1659 x 2212 pixels: 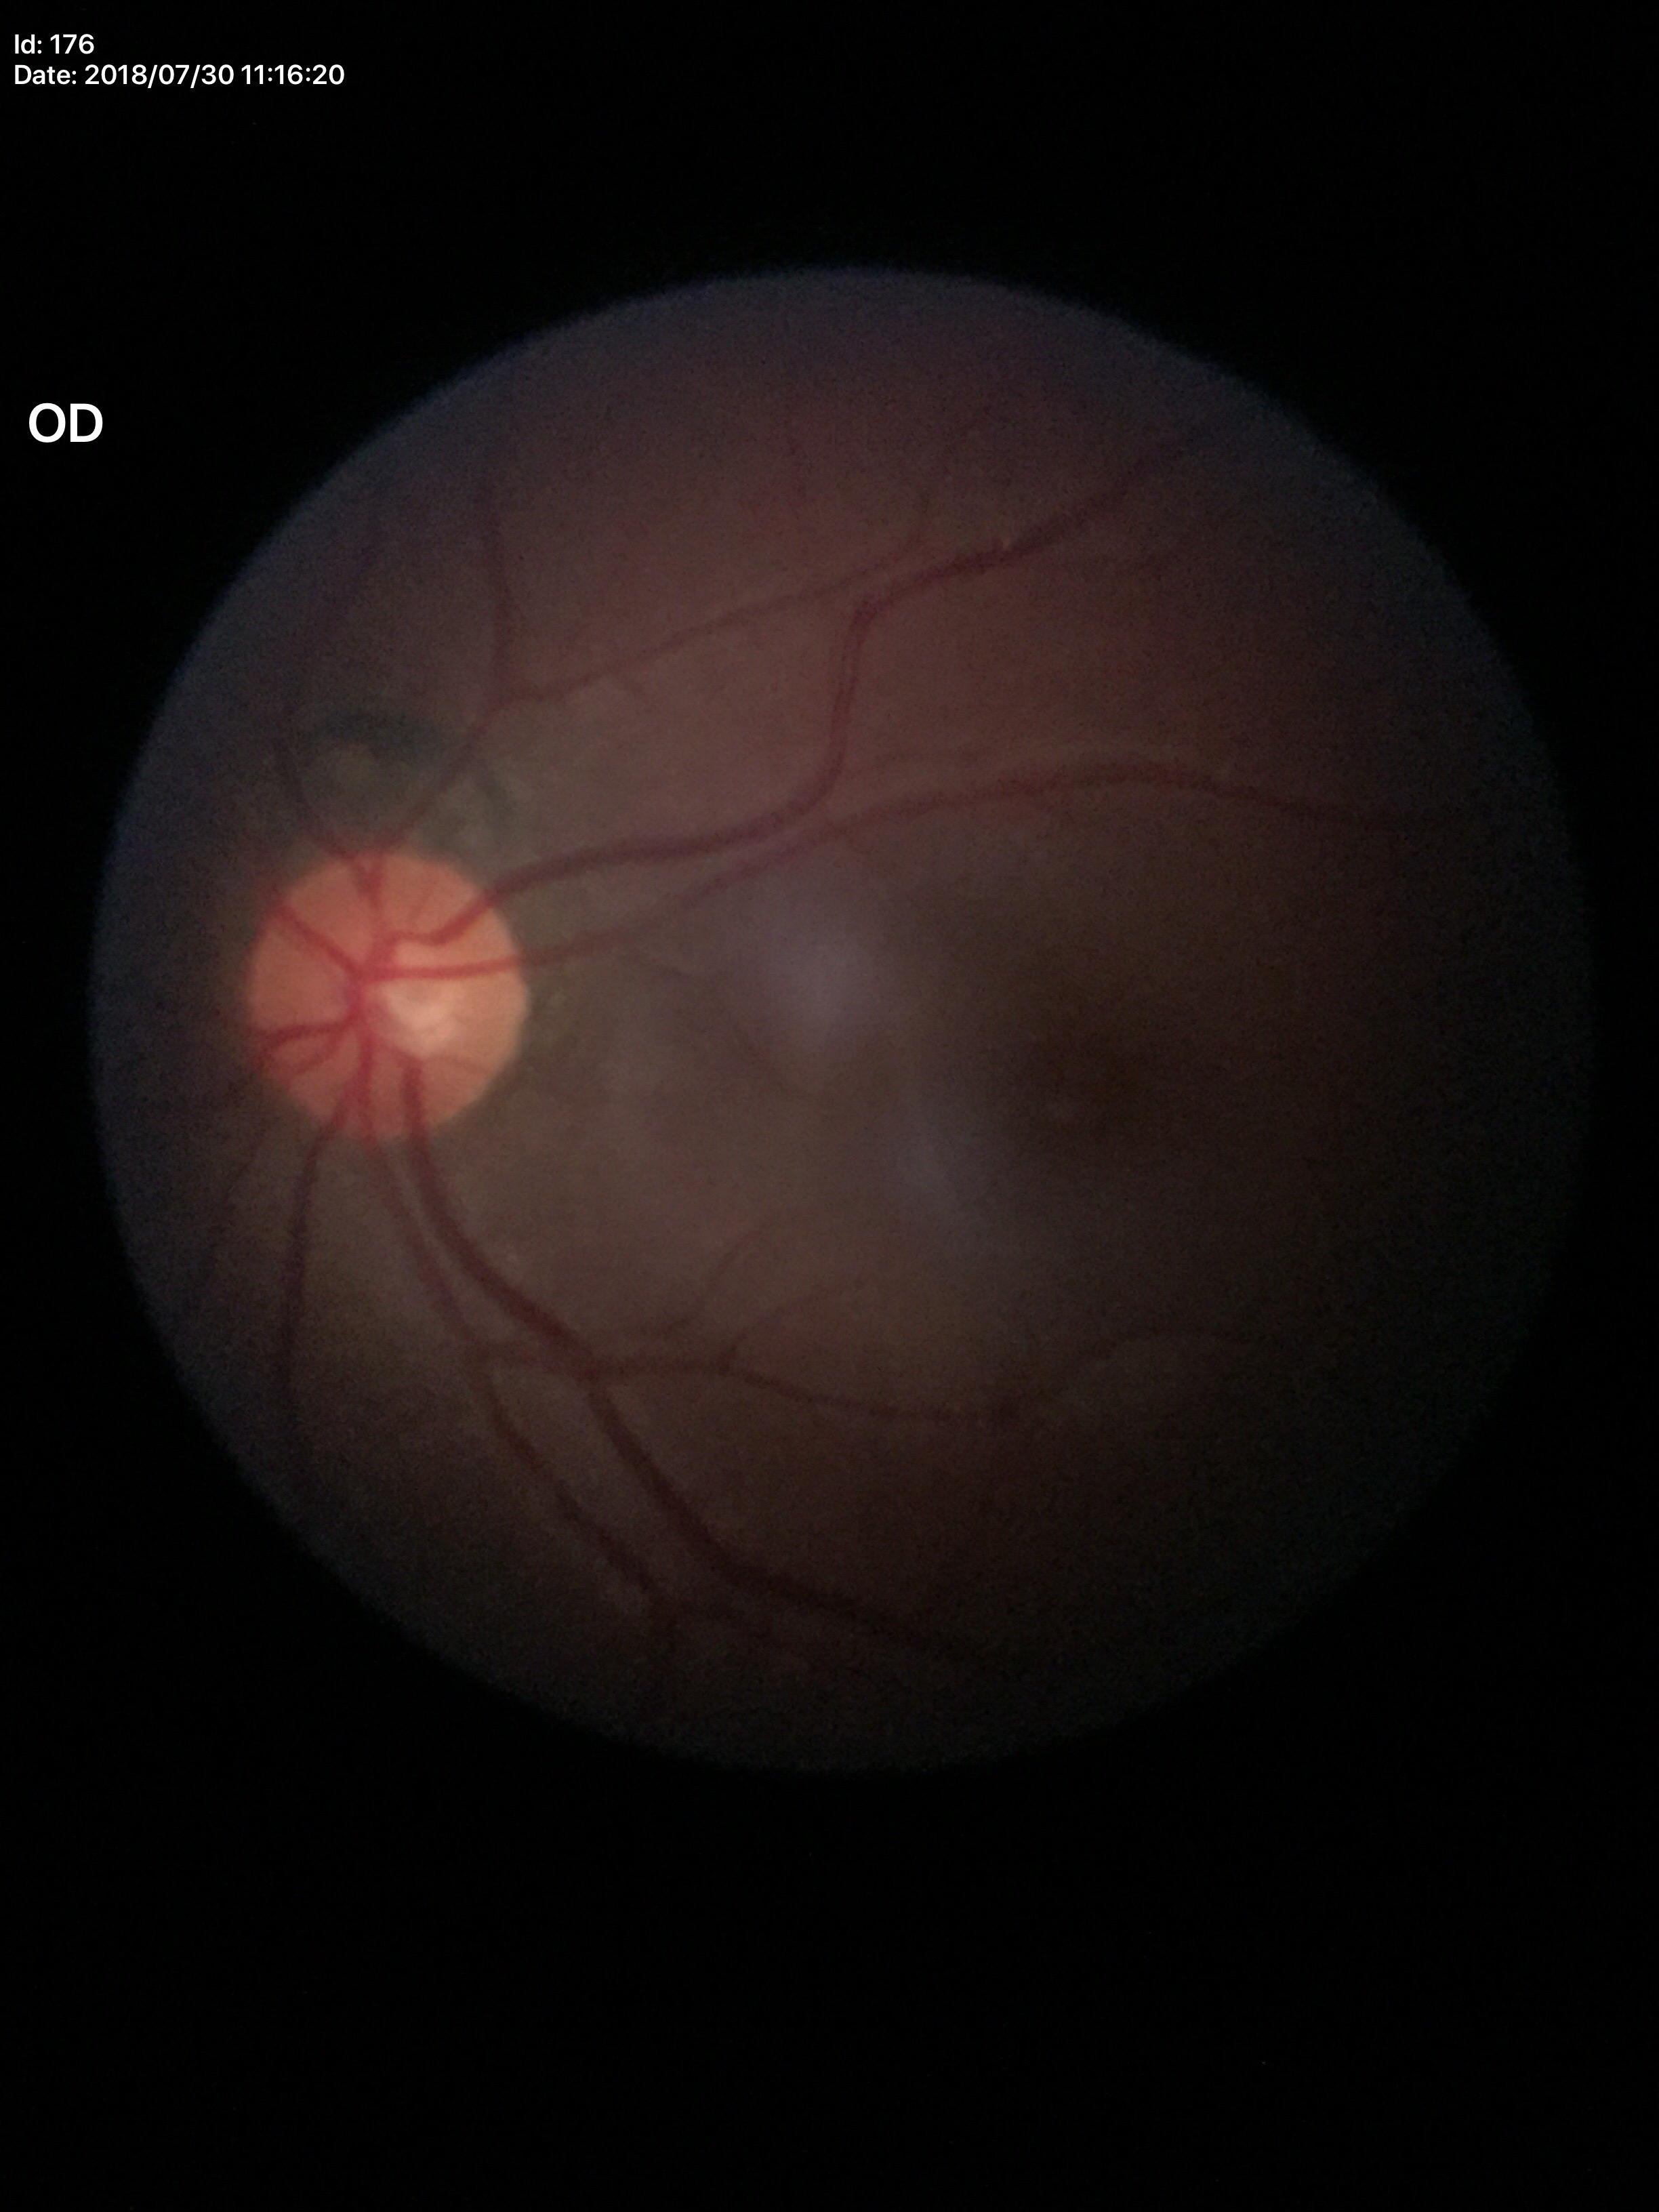
Horizontal C/D ratio of 0.48. Glaucoma decision: no suspicious findings. Vertical CDR is 0.46.